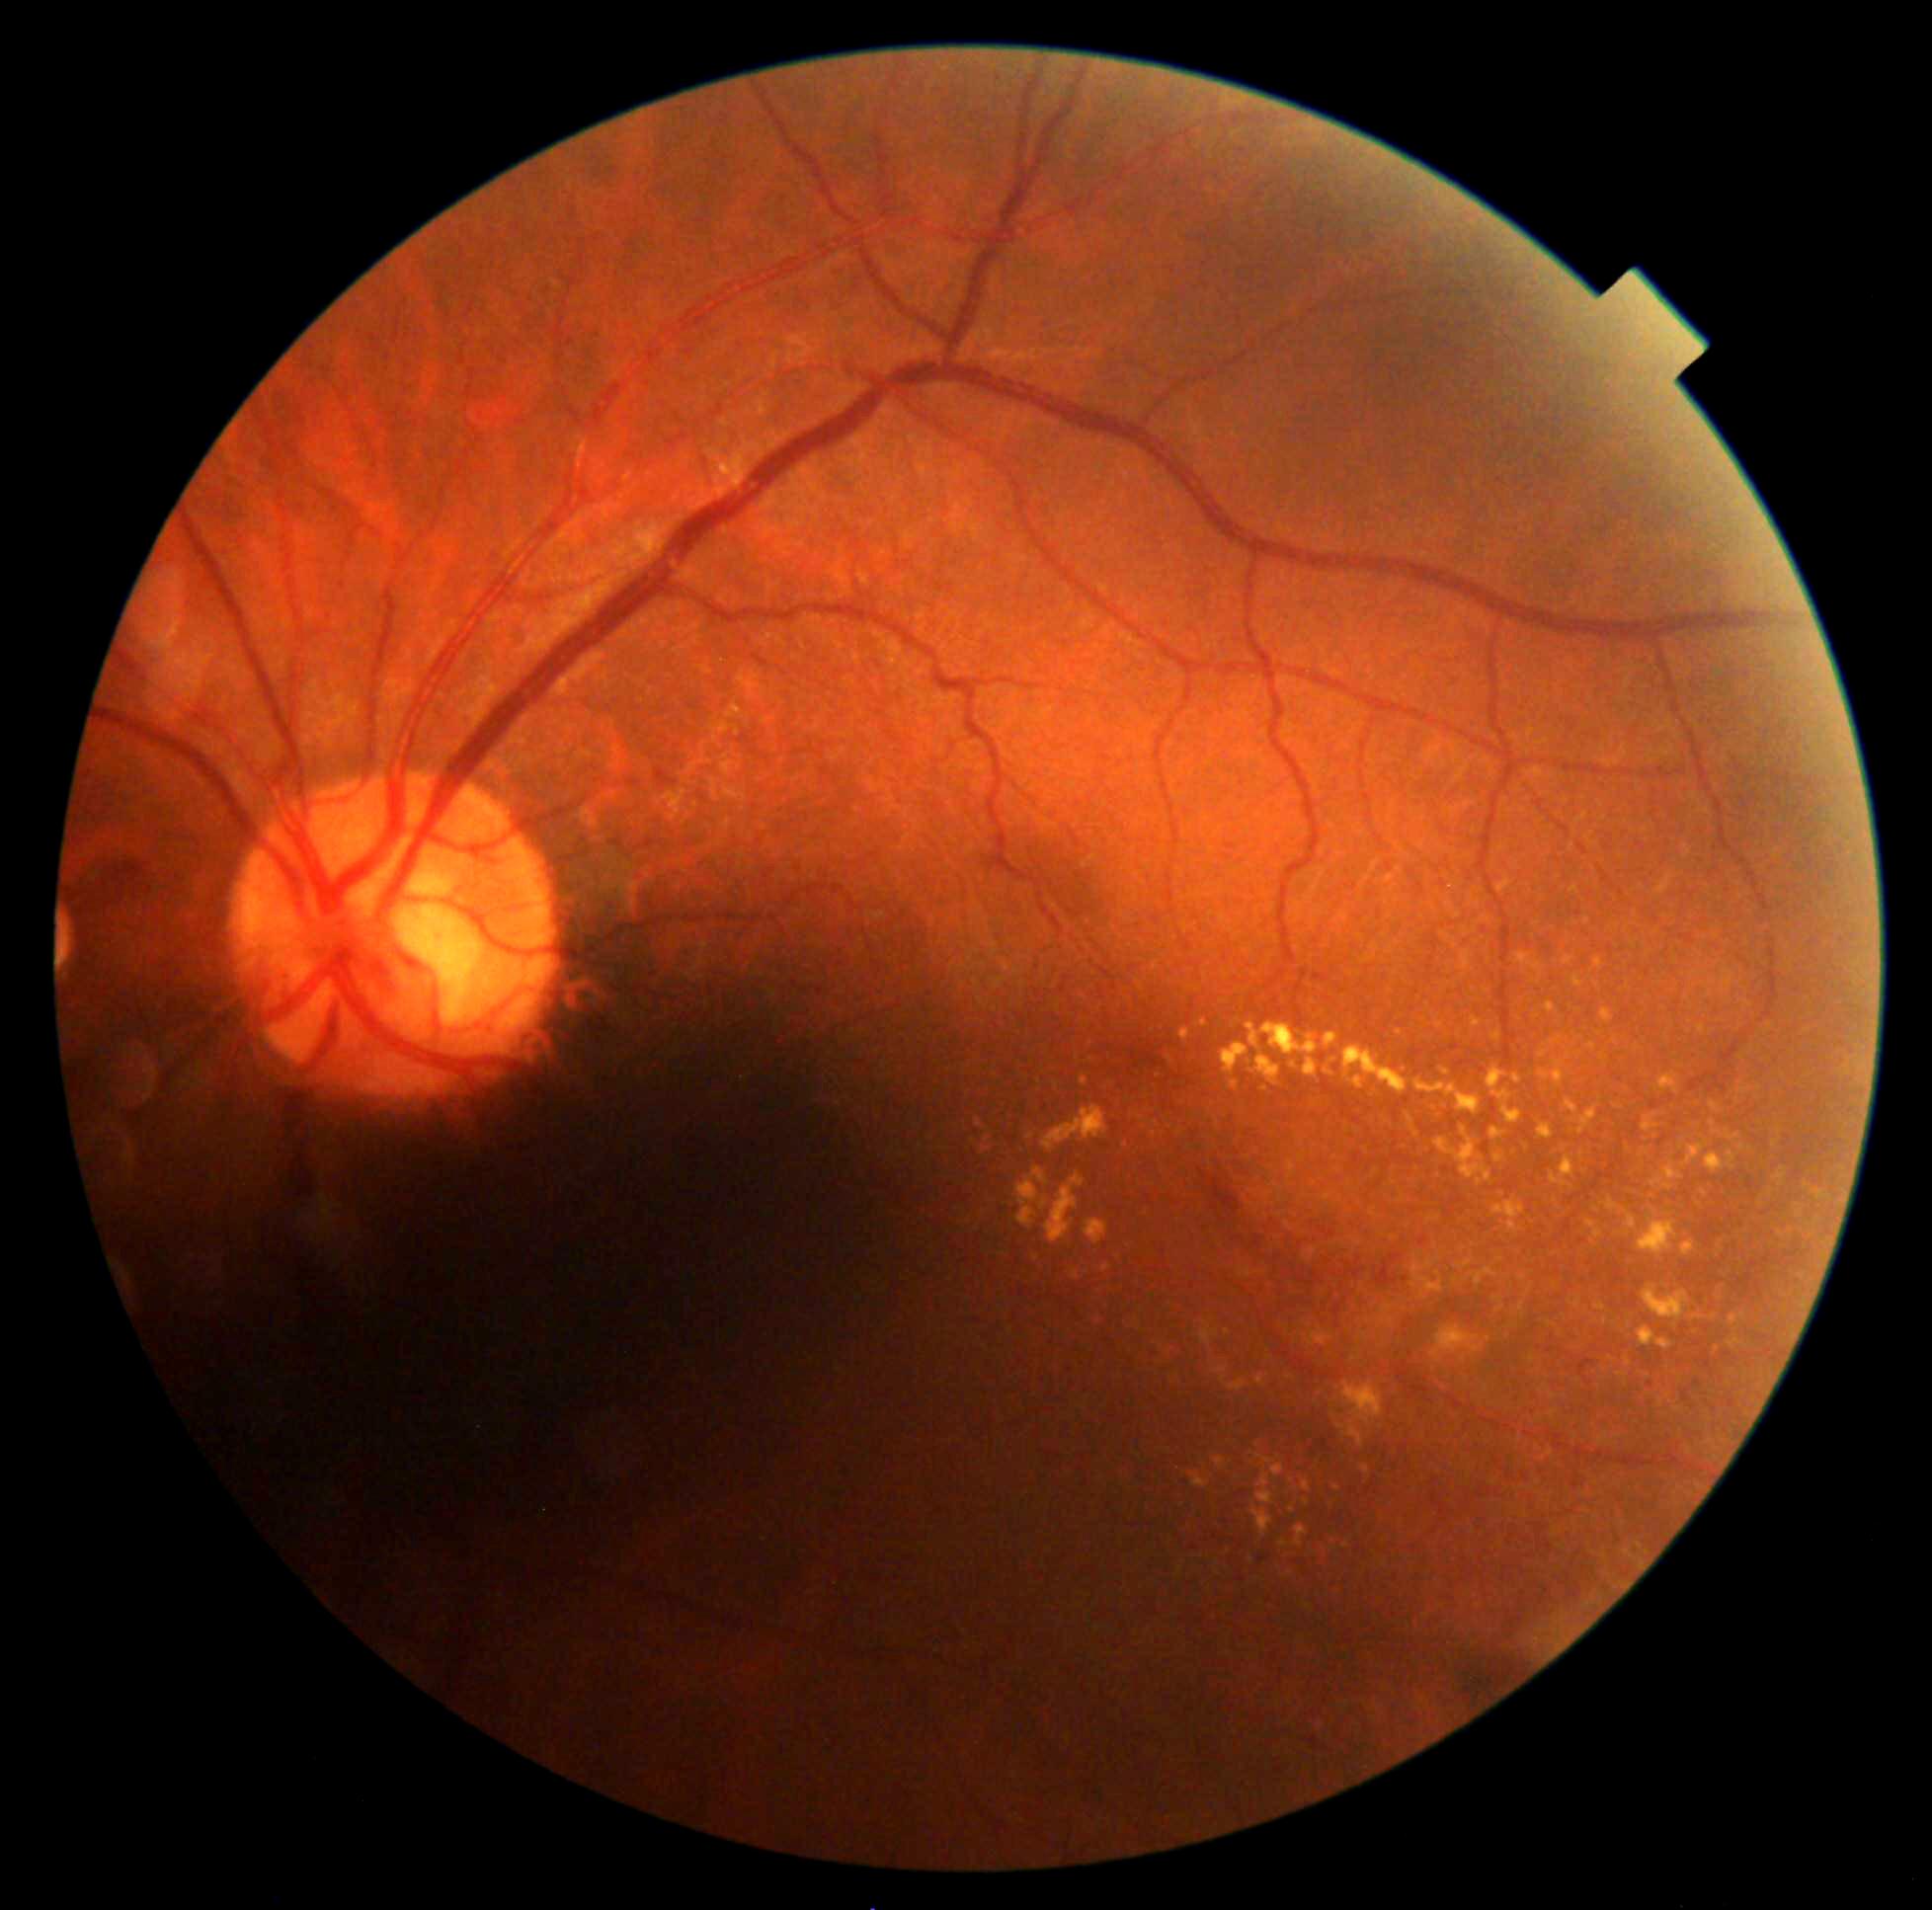
DR: grade 2 (moderate NPDR)
Selected lesions:
EXs (subset): <box>1682,1143,1709,1167</box>; <box>1546,1002,1557,1013</box>; <box>1408,1116,1420,1139</box>; <box>1729,1314,1746,1327</box>; <box>1793,1330,1797,1340</box>; <box>1651,1162,1685,1193</box>; <box>1176,1567,1183,1578</box>; <box>1073,1272,1080,1281</box>; <box>1718,1241,1725,1255</box>; <box>1658,1073,1680,1096</box>; <box>1212,1367,1230,1376</box>; <box>1414,1079,1481,1116</box>
EXs (small, approximate centers) near (x=1292, y=1481); (x=1464, y=1360); (x=1228, y=1333); (x=1307, y=1502); (x=1597, y=985); (x=1593, y=1242); (x=1168, y=1354)